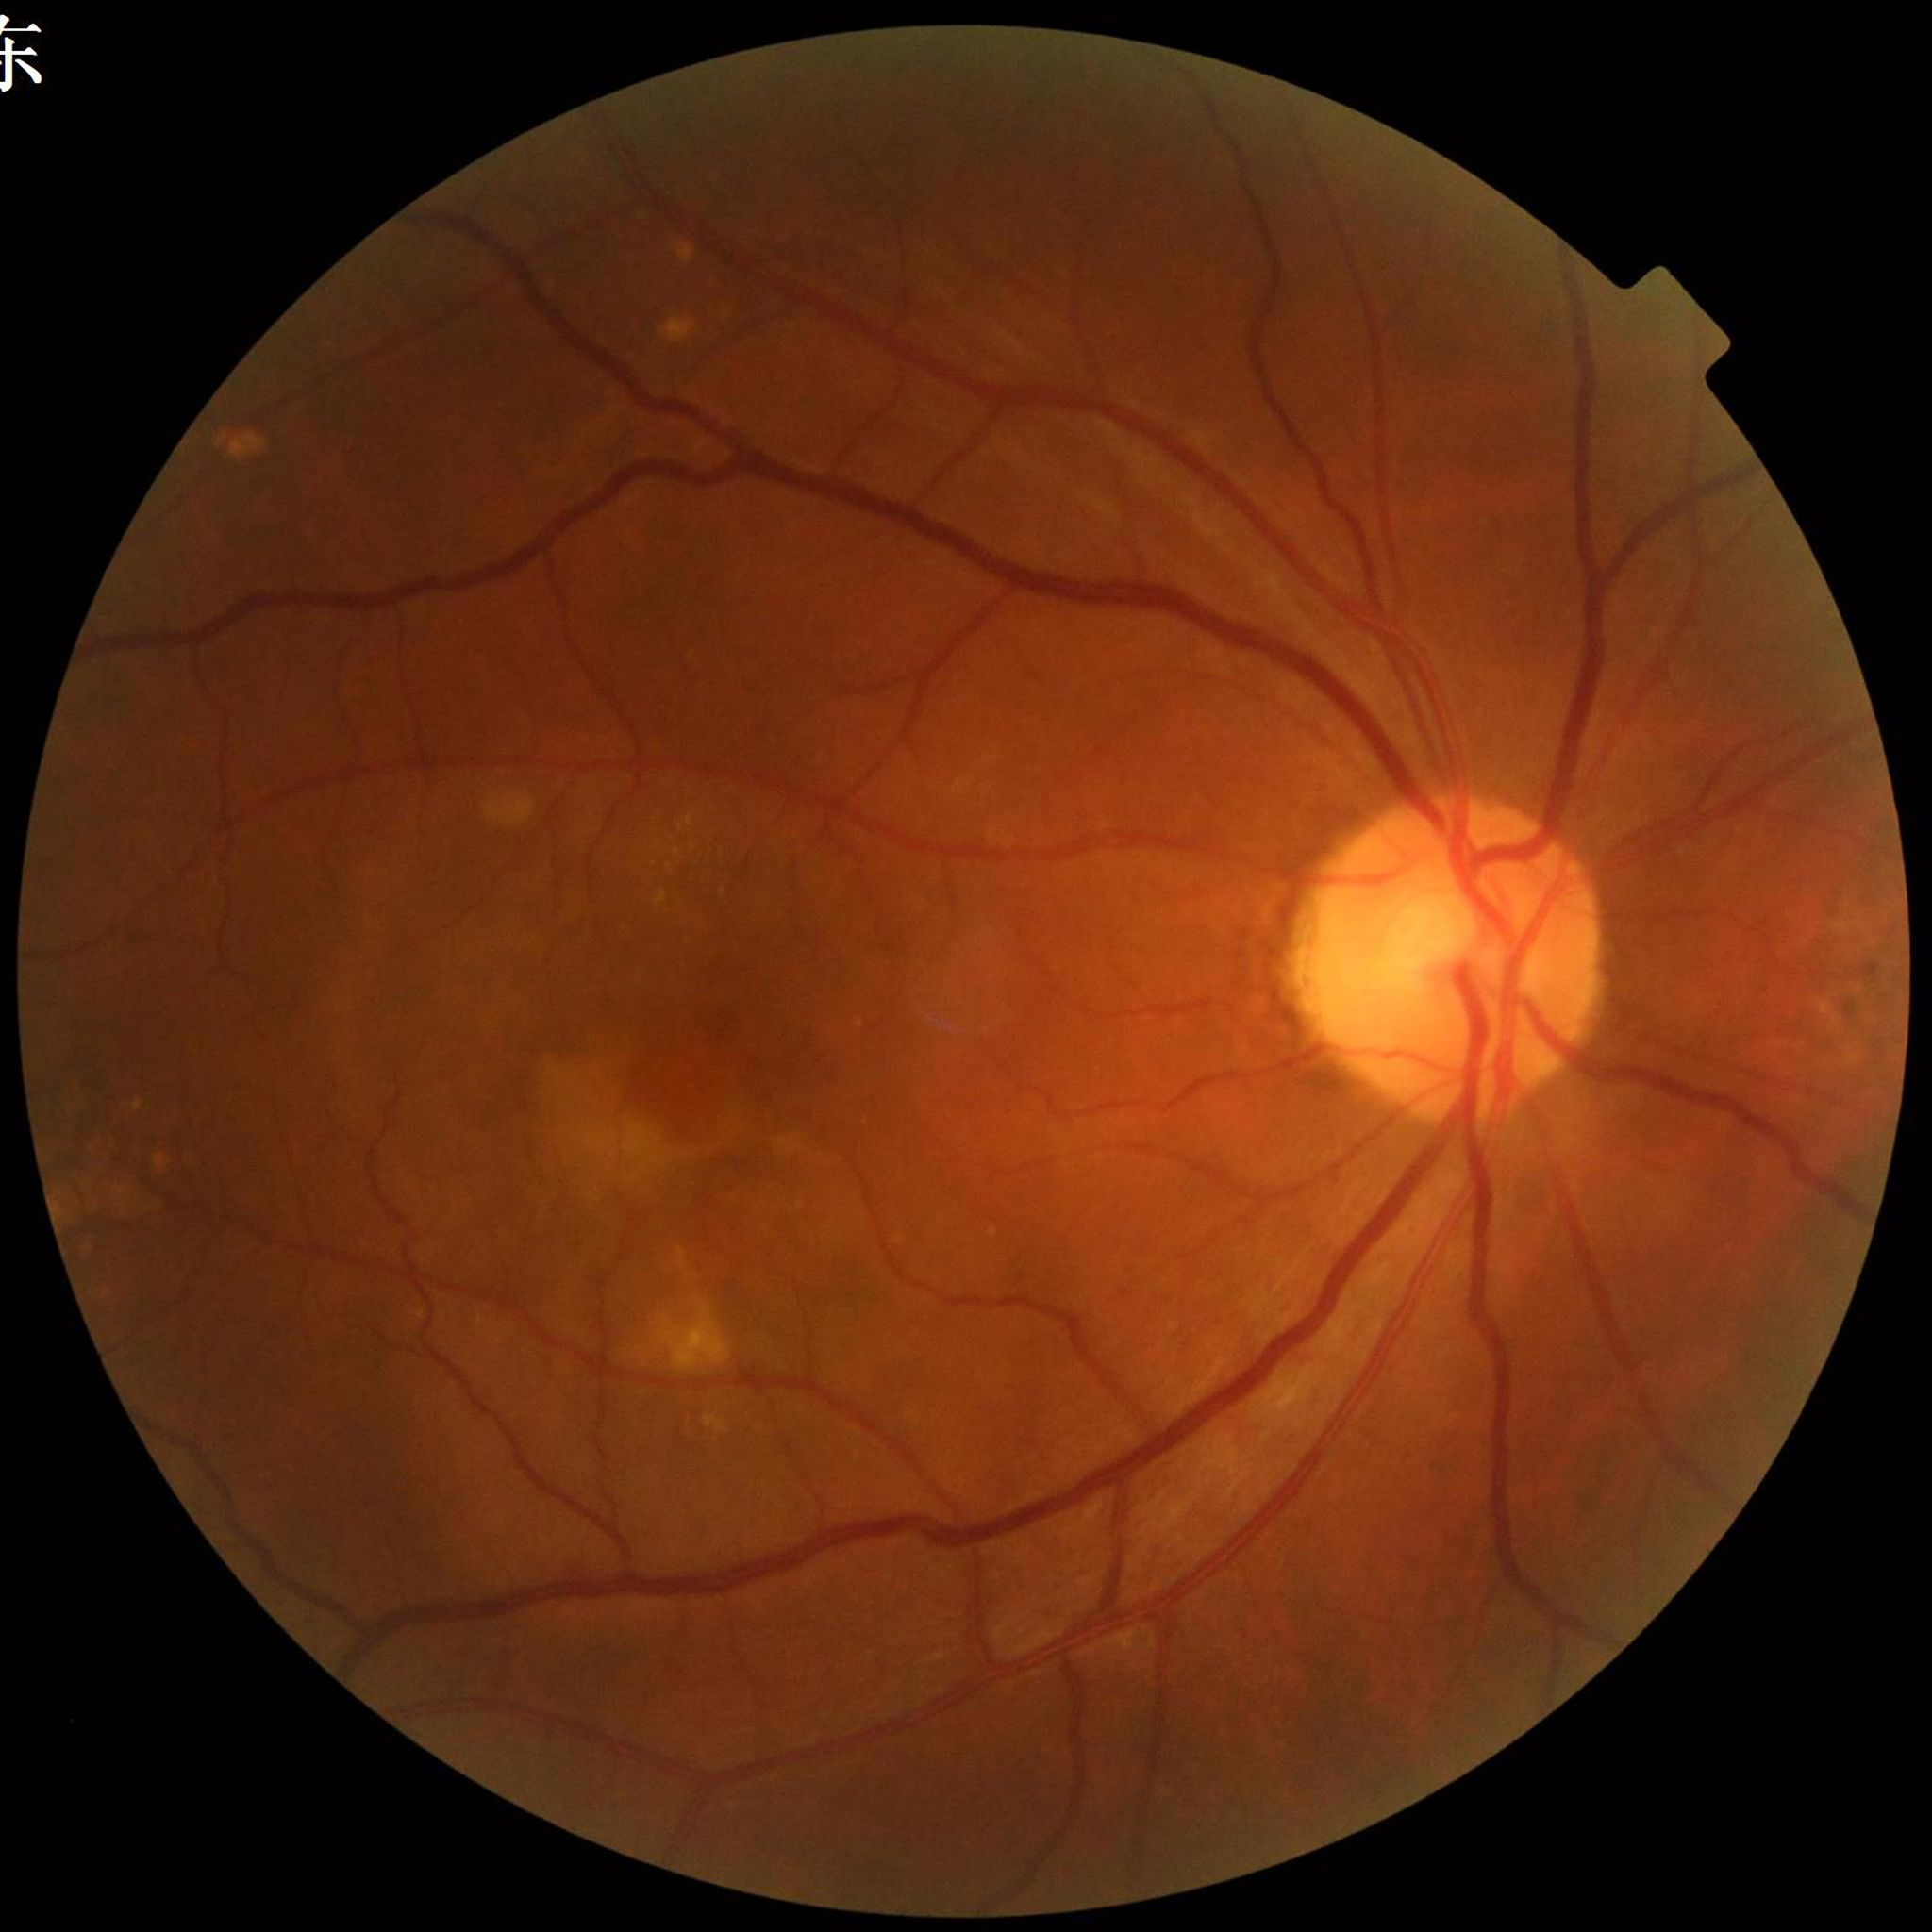
Fundus image of an eye with AMD.